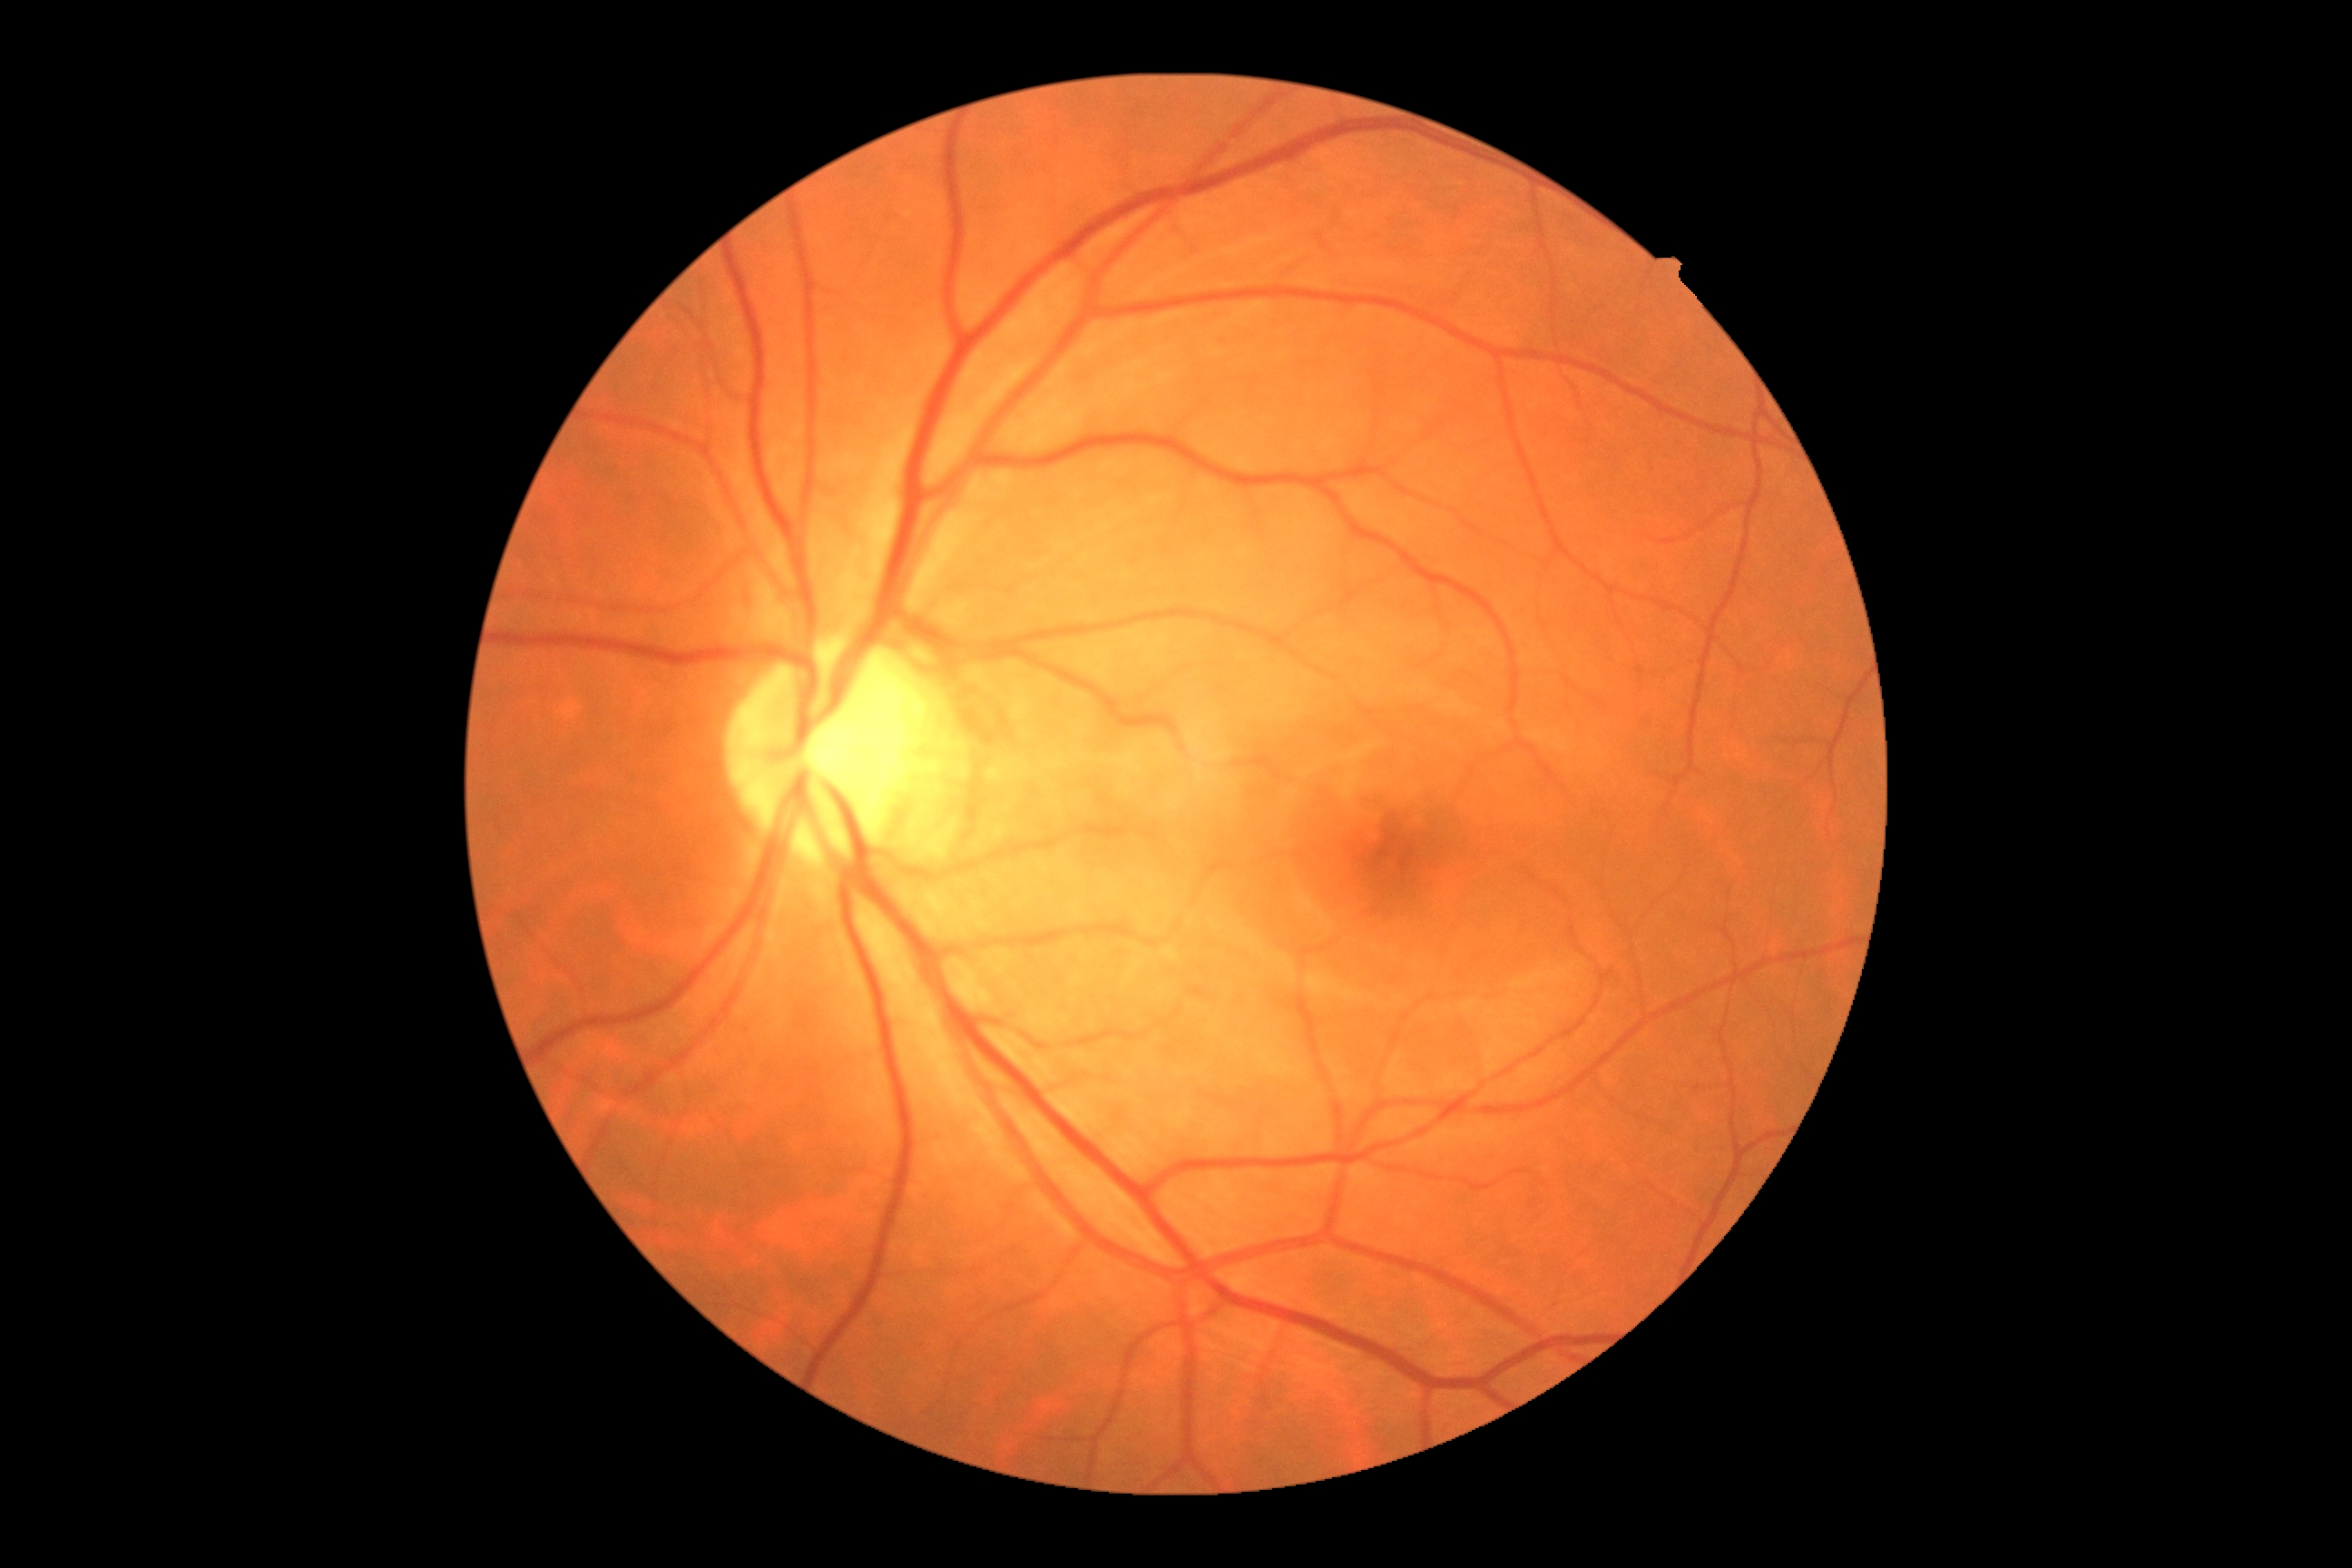

Annotations:
* diabetic retinopathy (DR): 0/4